Modified Davis classification; image size 848x848; without pupil dilation; acquired with a NIDEK AFC-230; 45 degree fundus photograph
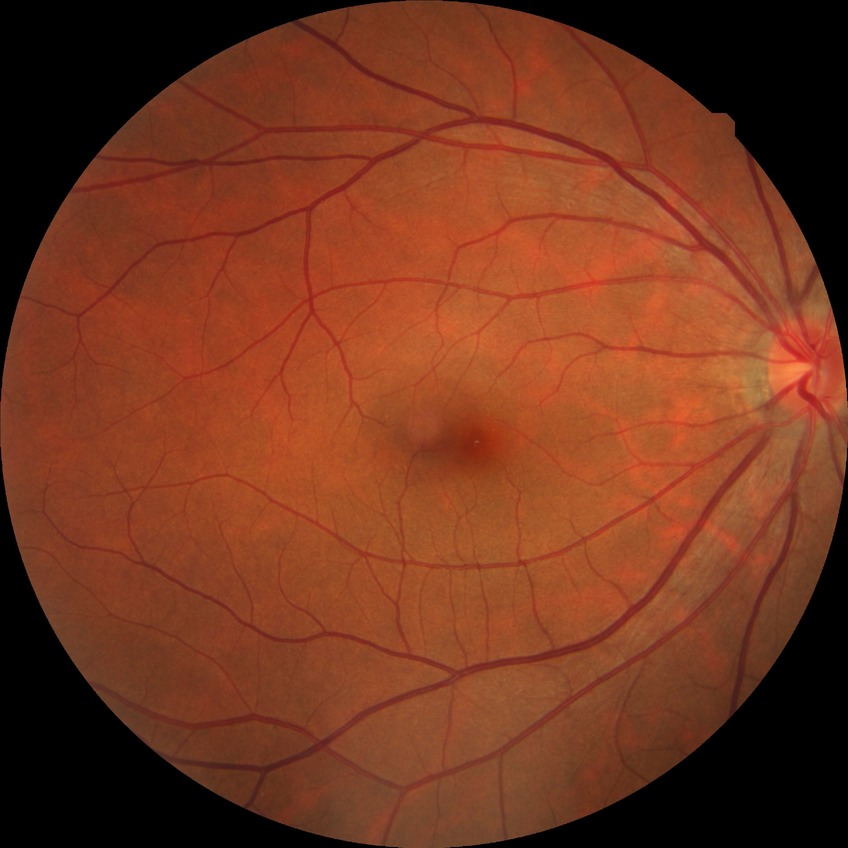 Diabetic retinopathy (DR) is NDR (no diabetic retinopathy).